Image size 2352x1568 — 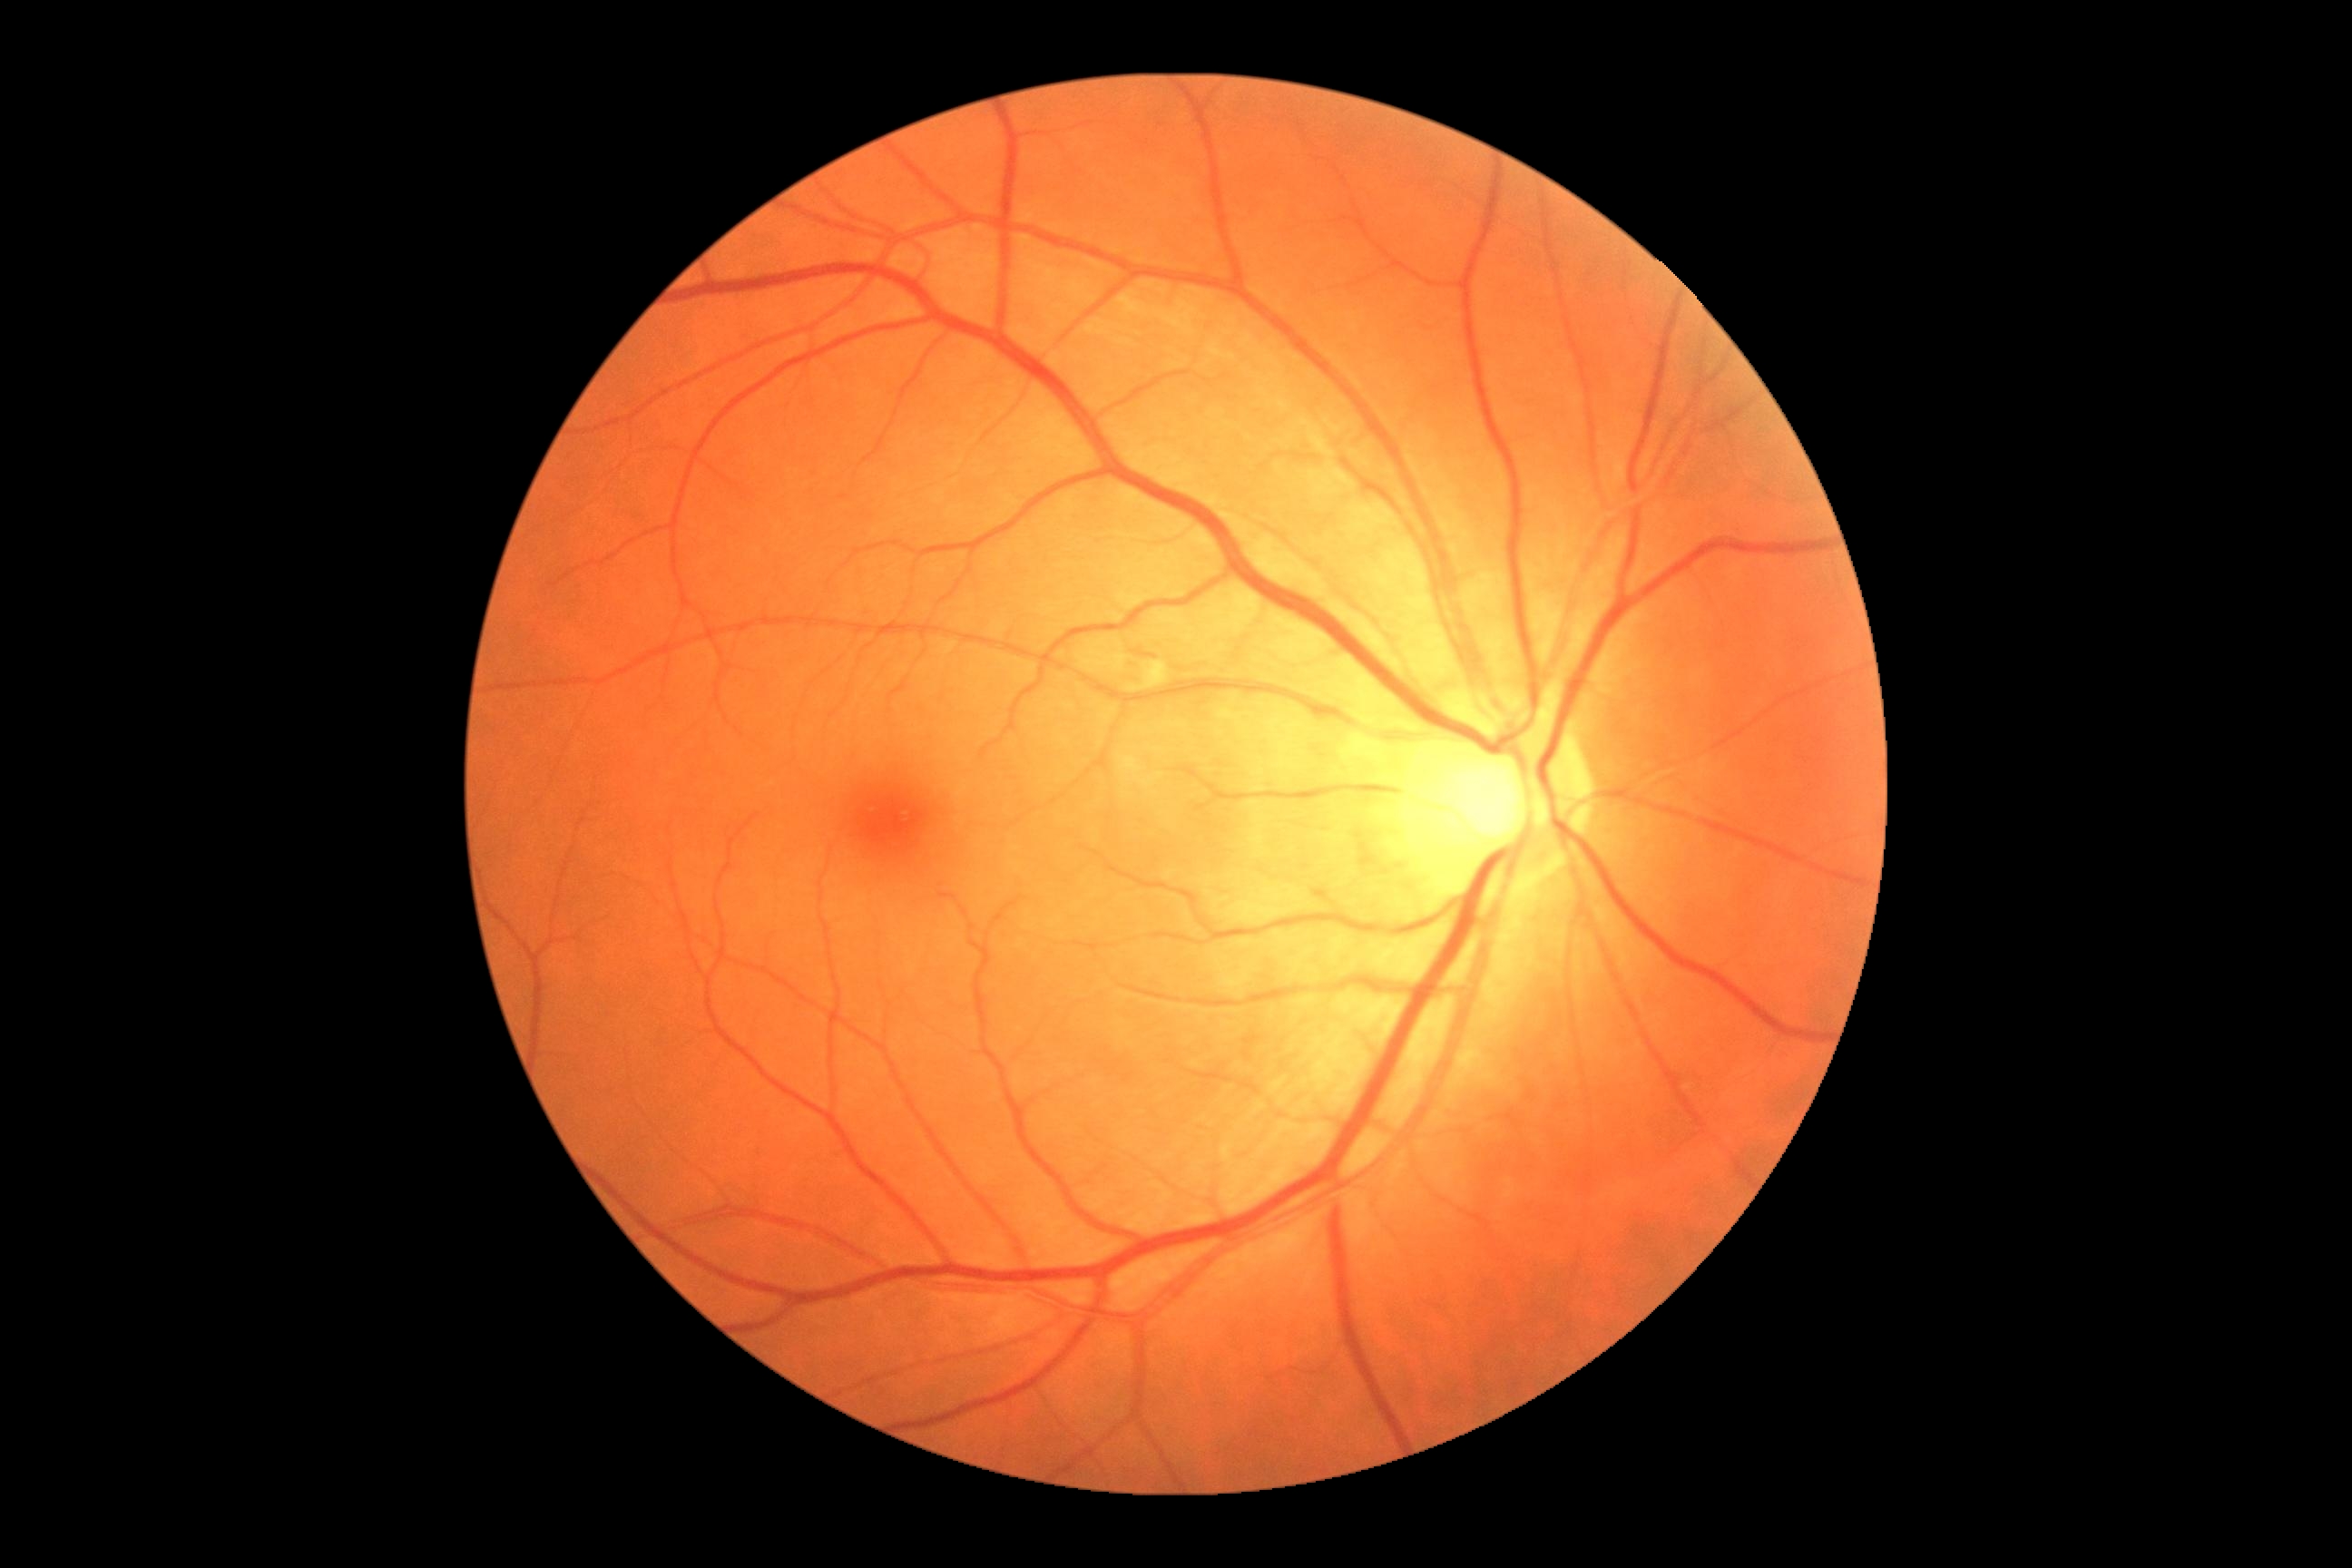

DR severity = grade 2.